Nidek AFC-330: 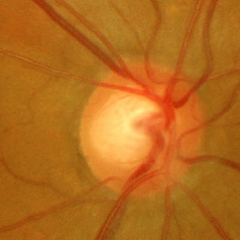
Q: What stage of glaucoma is present?
A: Early glaucomatous optic neuropathy.